Wide-field fundus photograph from neonatal ROP screening · acquired on the Clarity RetCam 3: 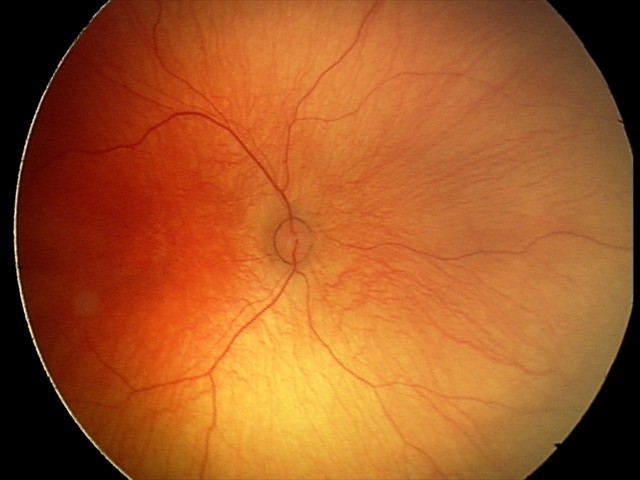 Q: What was the screening finding?
A: no abnormal retinal findings